2048 x 1536 pixels: 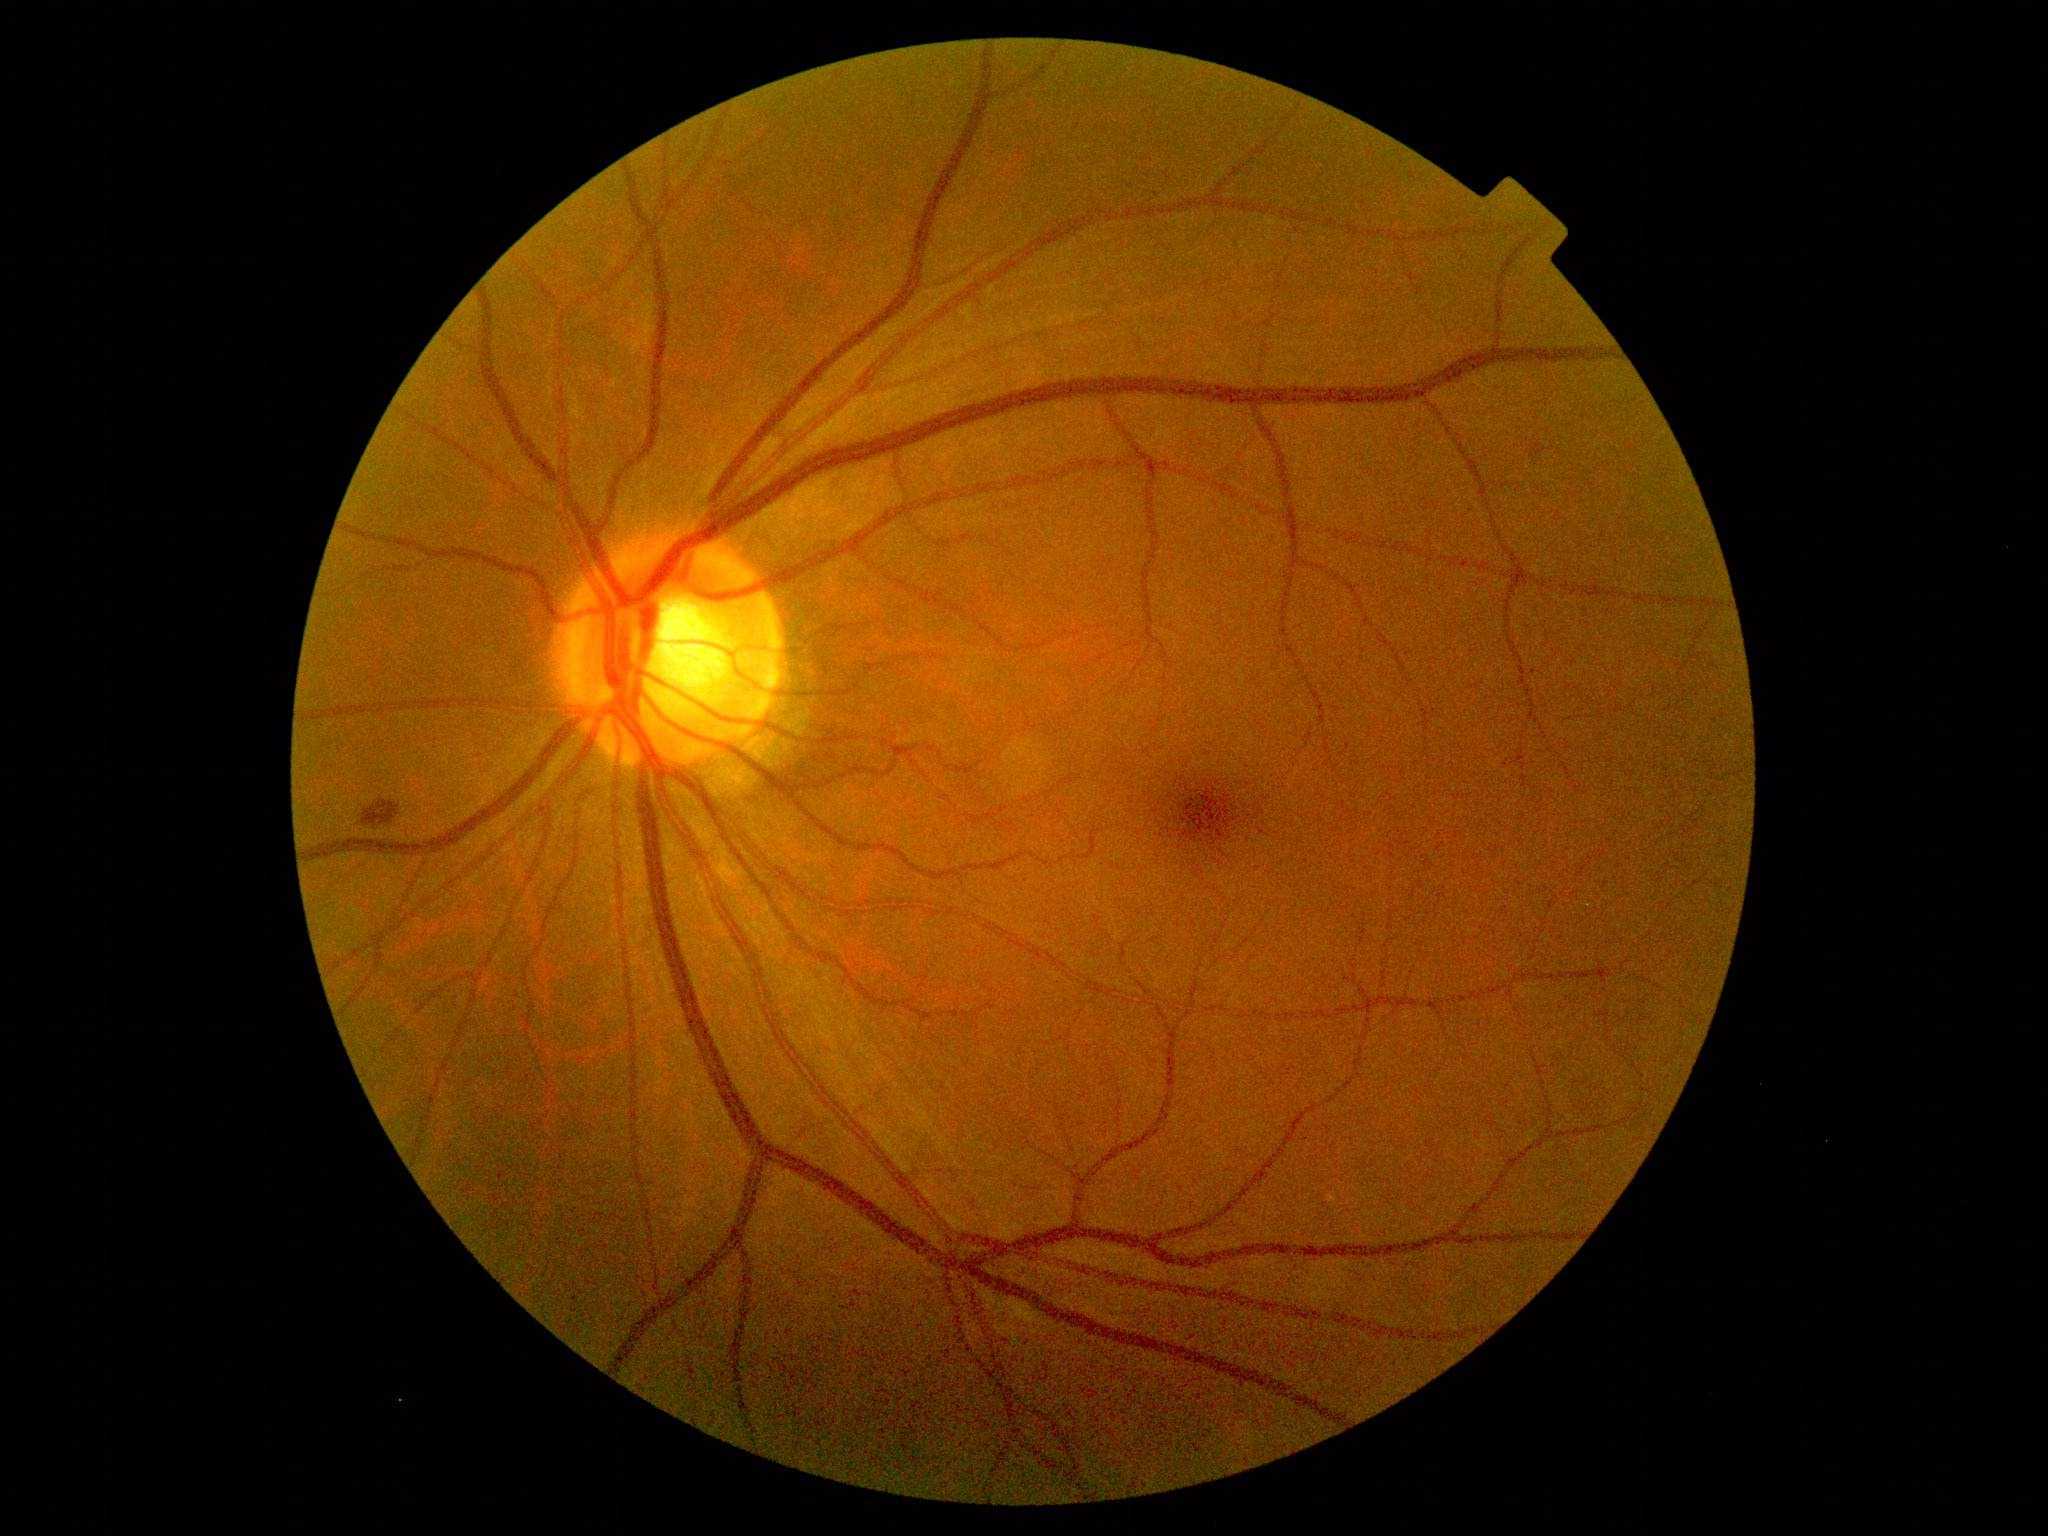
Diabetic retinopathy (DR): grade 2 (moderate NPDR)
• hemorrhages (HEs): 363, 798, 401, 828
• hard exudates (EXs): none
• microaneurysms (MAs): none
• soft exudates (SEs): none